Color fundus image — 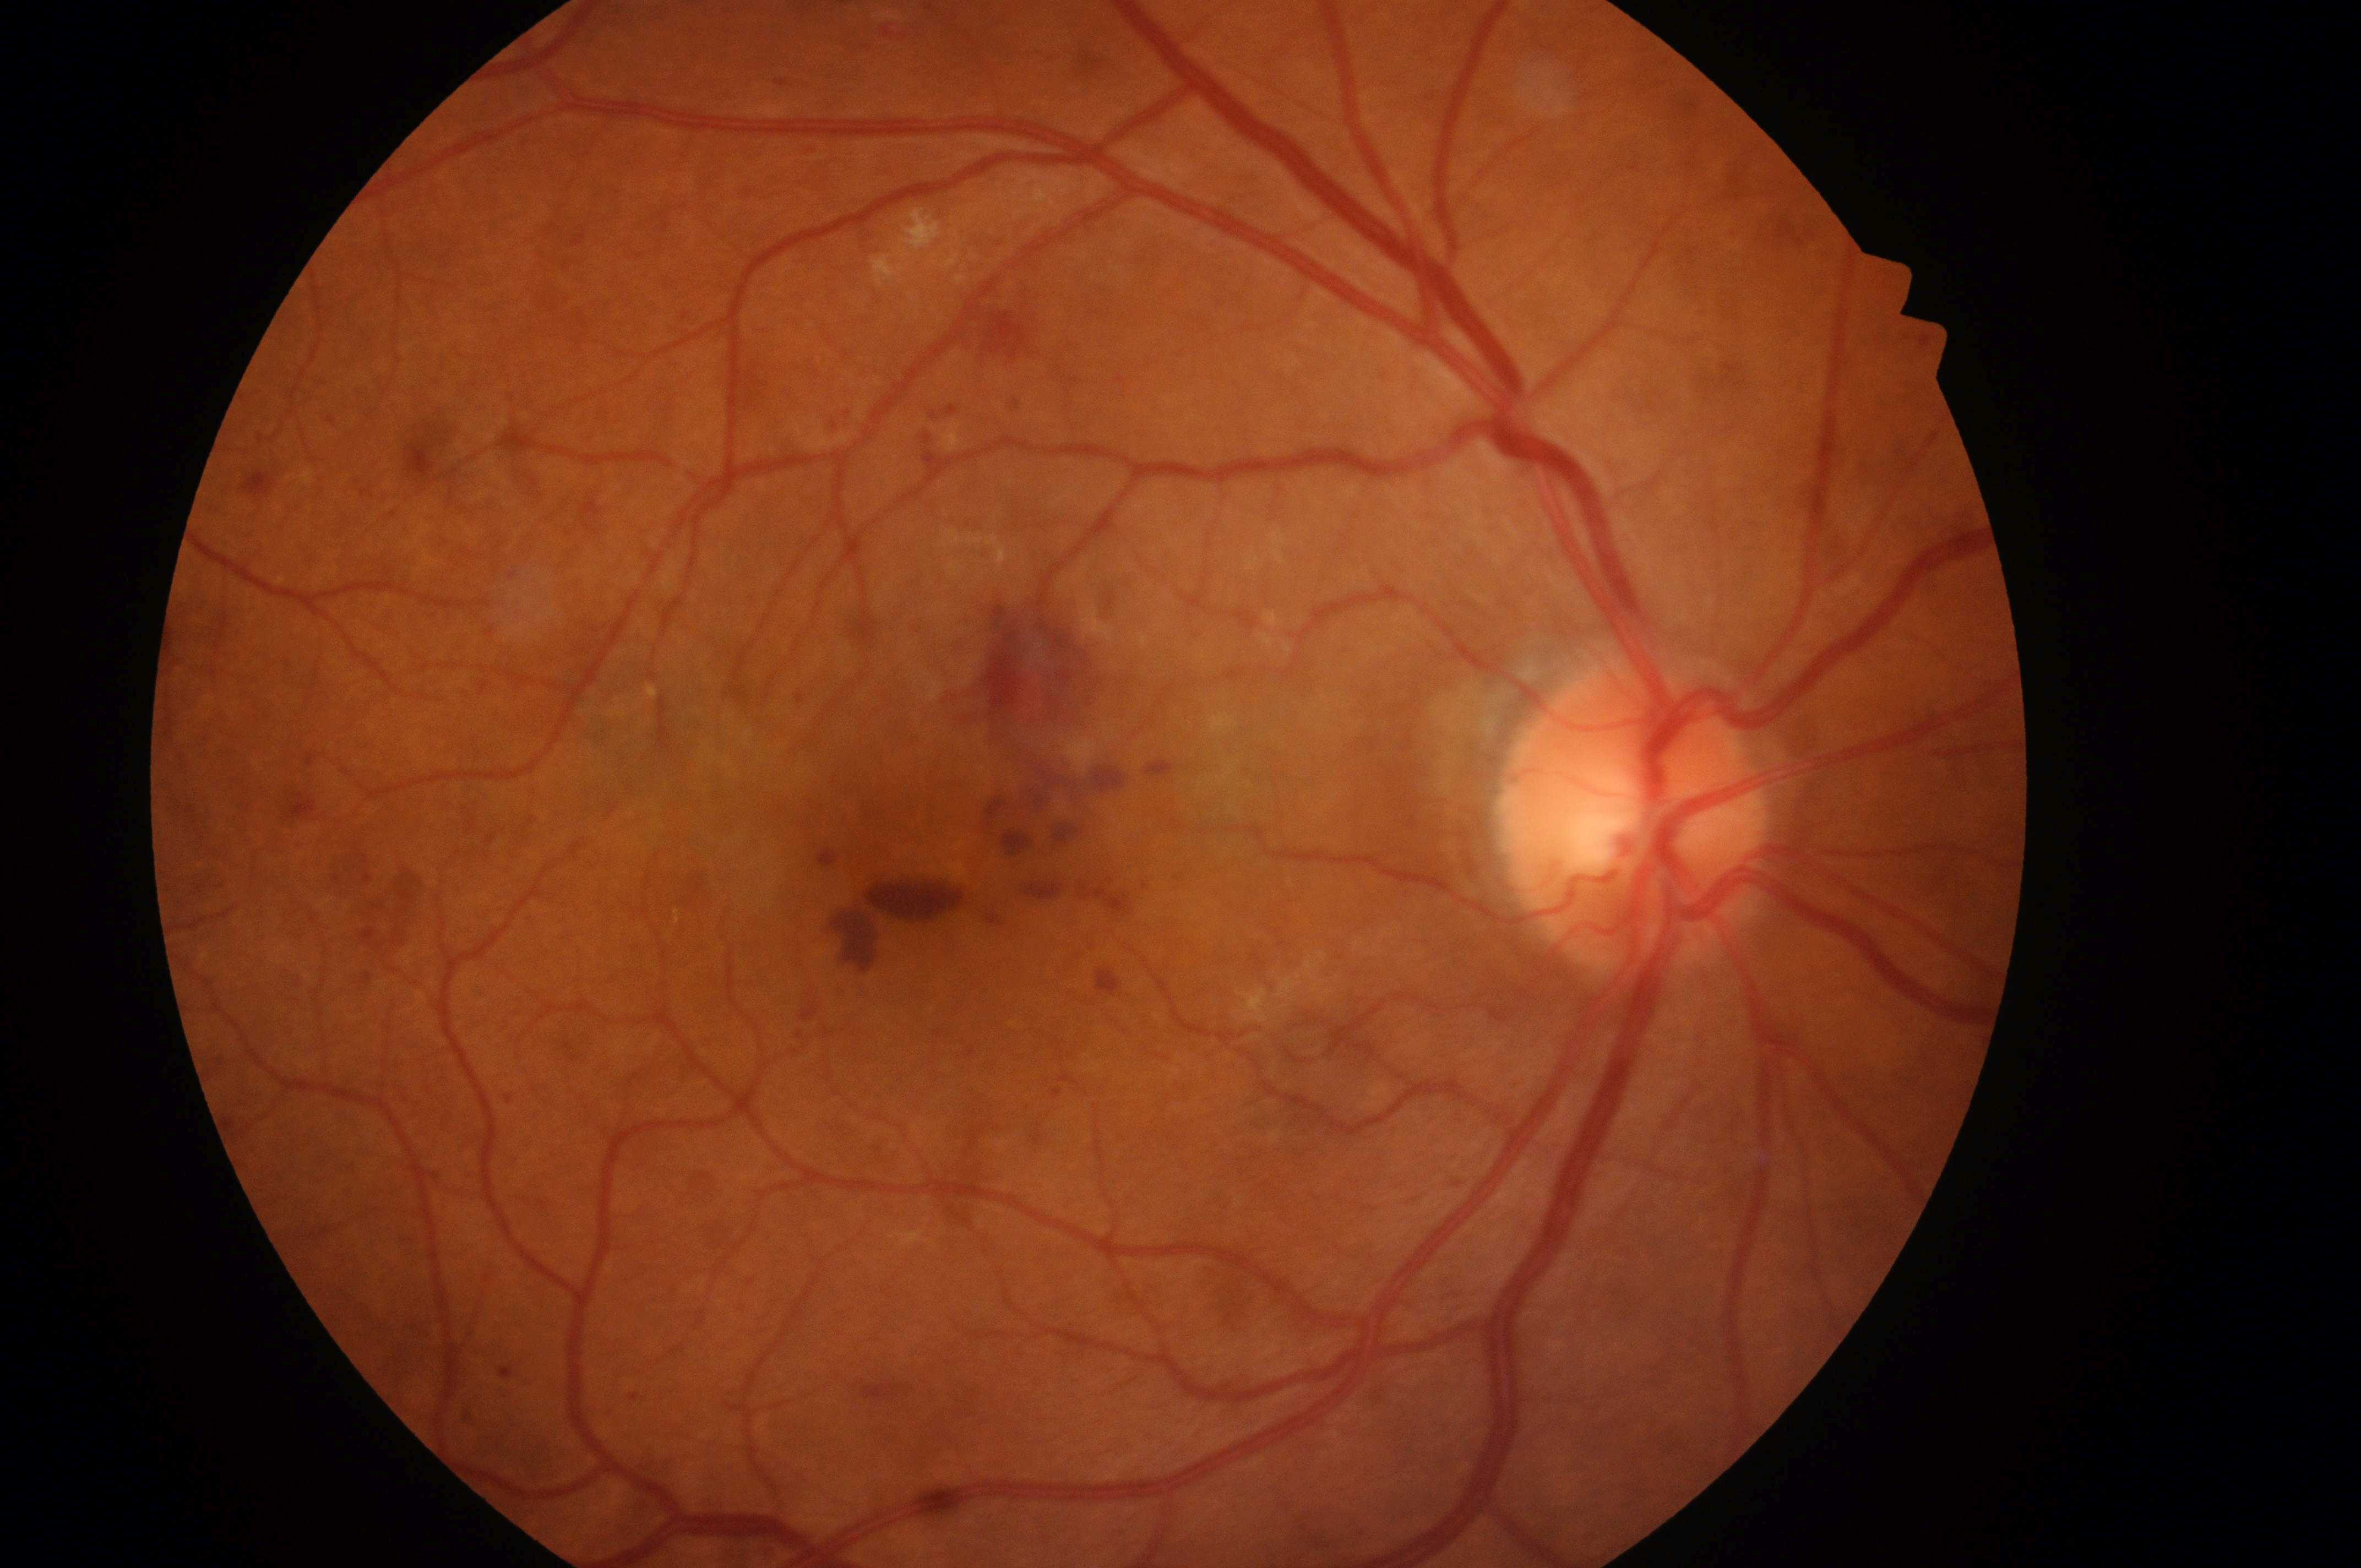

DME grade is low risk (1) — hard exudates present, but outside one disc diameter of the macula center.
Fovea centralis located at (961,870).
DR stage: severe non-proliferative diabetic retinopathy (grade 3) — more than 20 intraretinal hemorrhages in each of 4 quadrants, definite venous beading in 2 or more quadrants, or prominent intraretinal microvascular abnormalities in 1 or more quadrants, with no signs of proliferative retinopathy.
The ONH is at (1631,826).
Disease class: non-proliferative diabetic retinopathy.
Imaged eye: OD.